CFP — 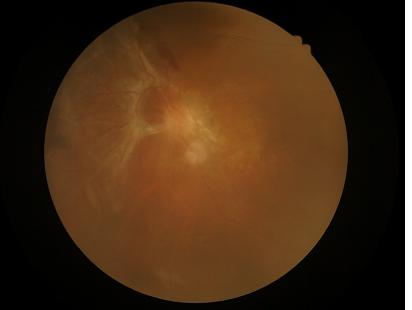

Illumination and color are suboptimal.
Noticeable blur in the optic disc, vessels, or background.
Acceptable image quality.
Poor dynamic range.